DR severity per modified Davis staging; without pupil dilation; fundus photo; 848x848
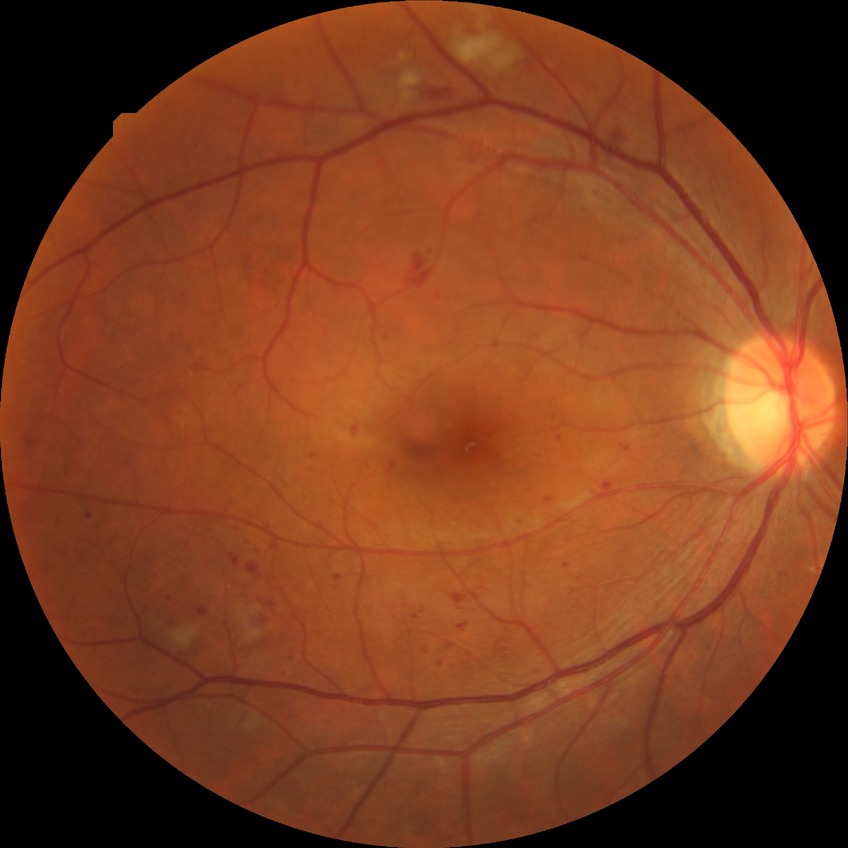
– modified Davis grading: pre-proliferative diabetic retinopathy